45° FOV, 2212x1659px.
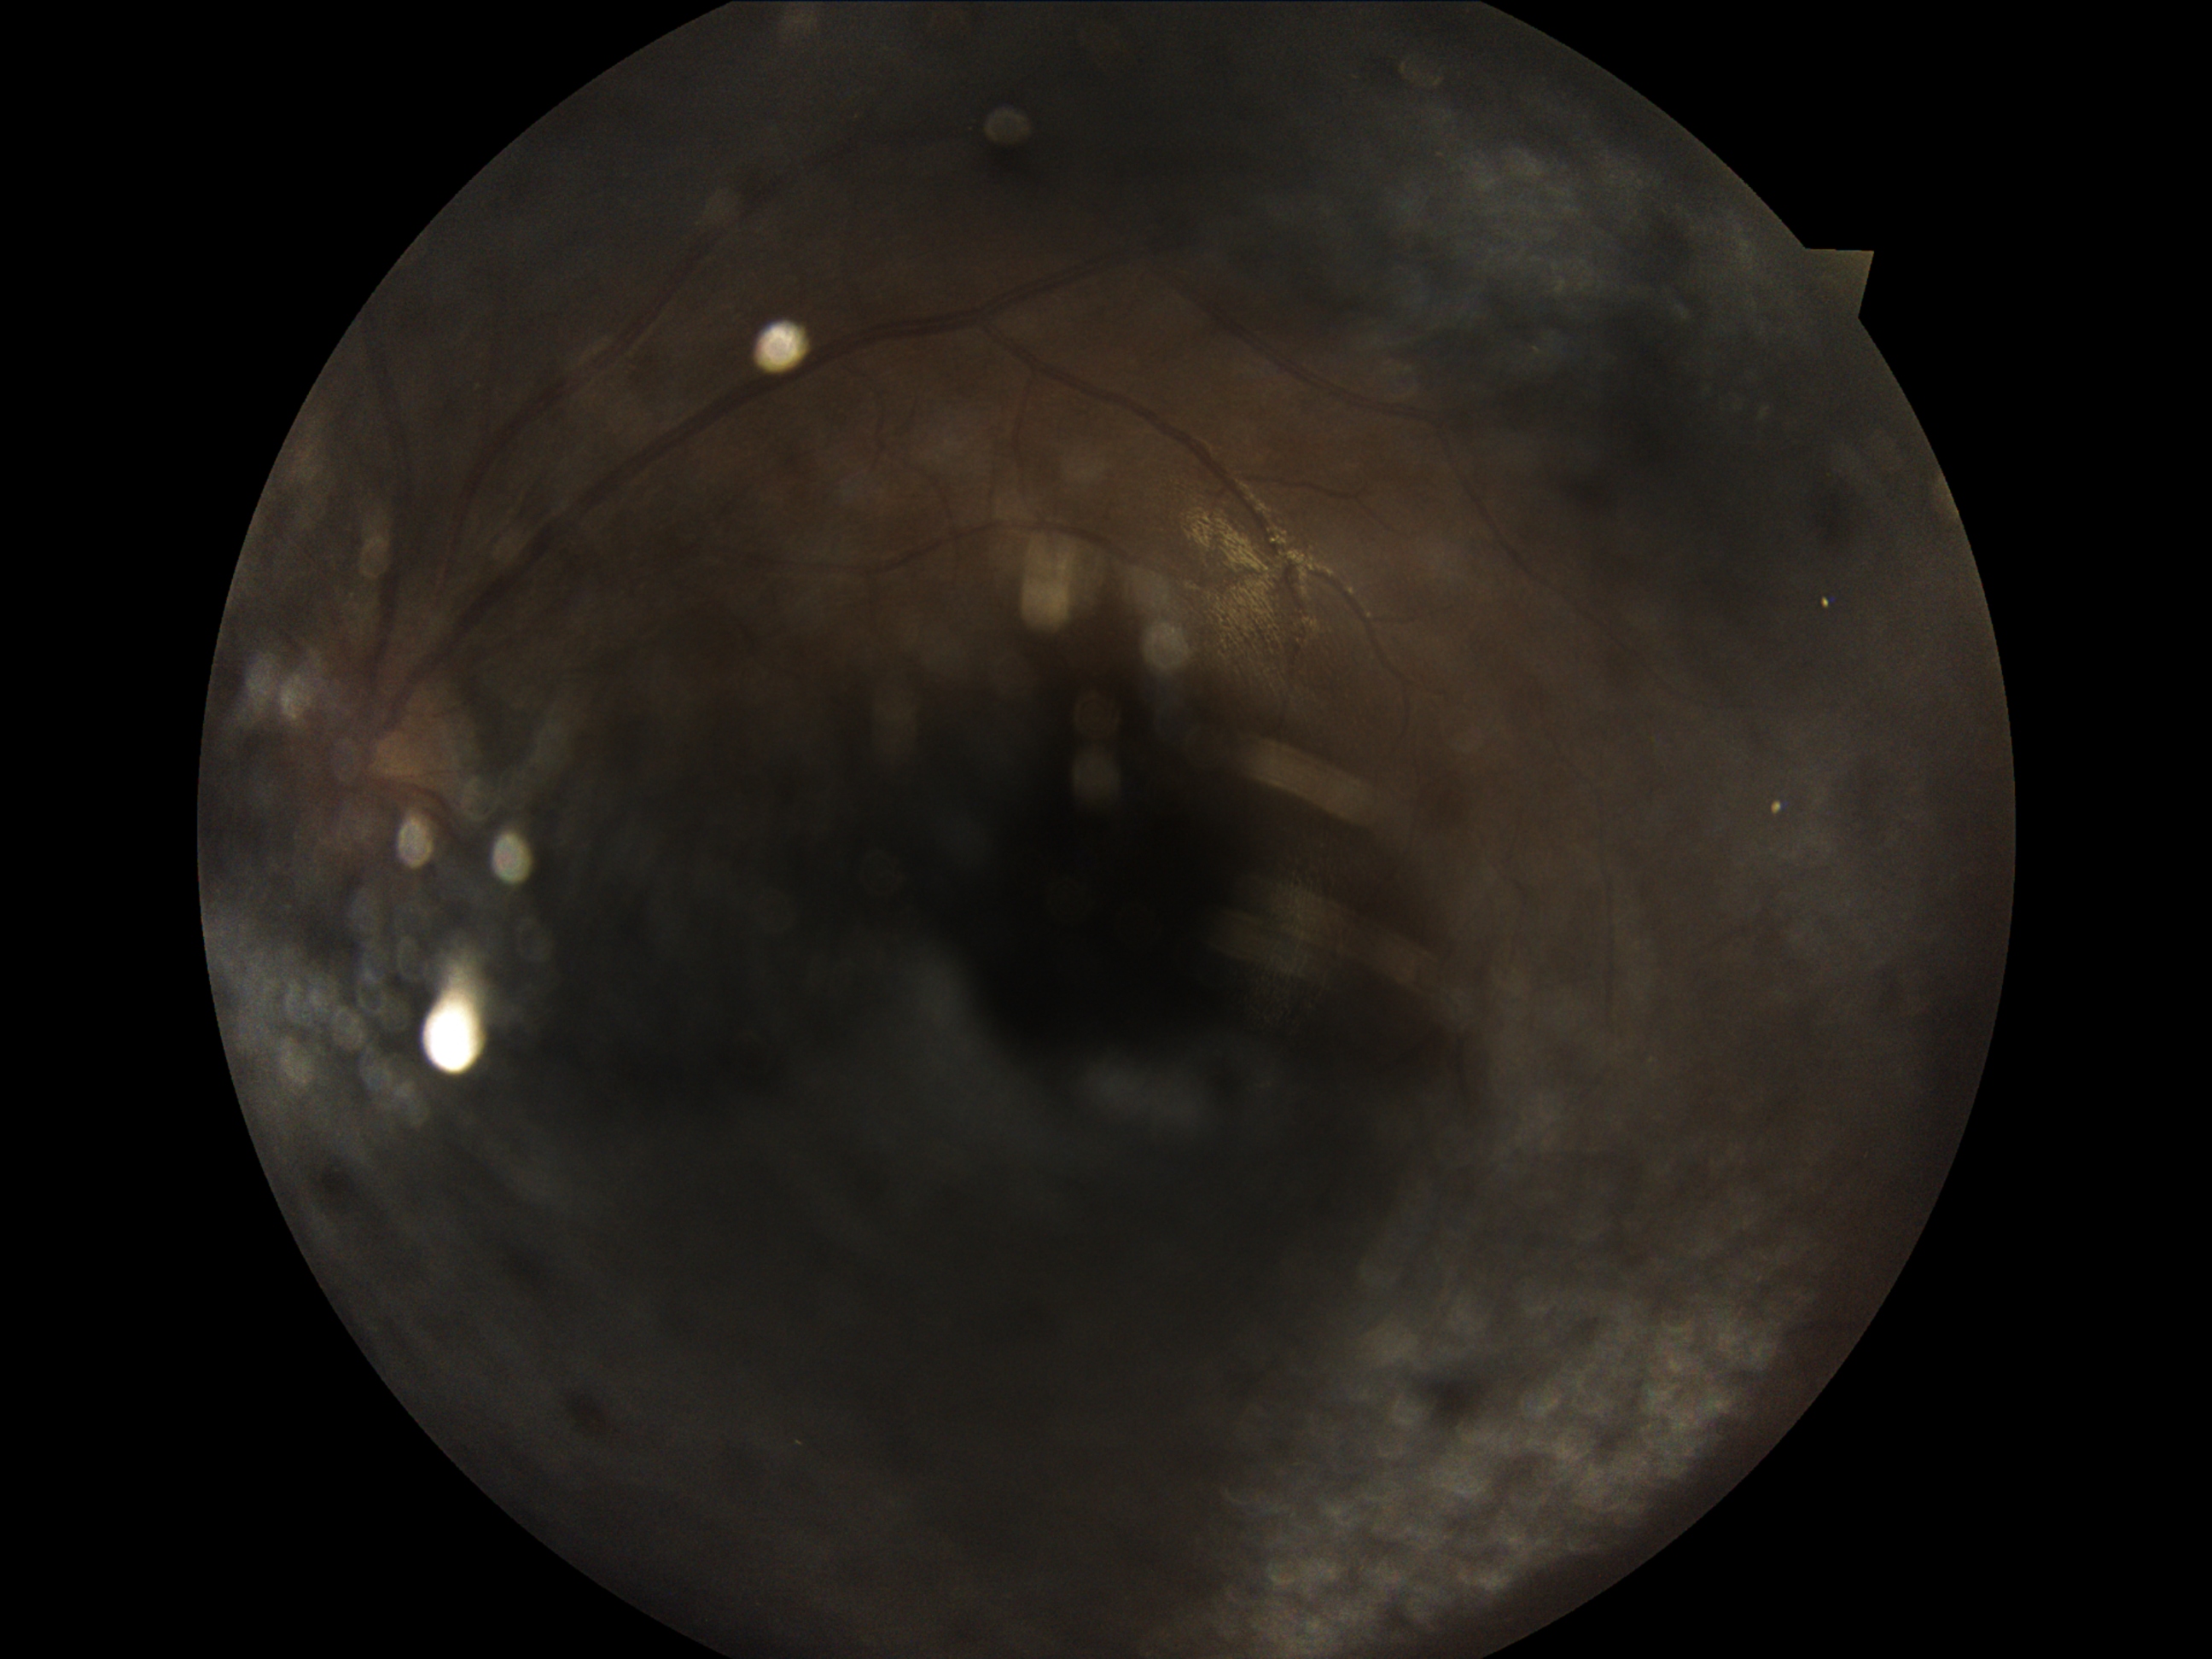

{
  "dr_grade": "ungradable"
}